Acquired with a NIDEK AFC-230 — 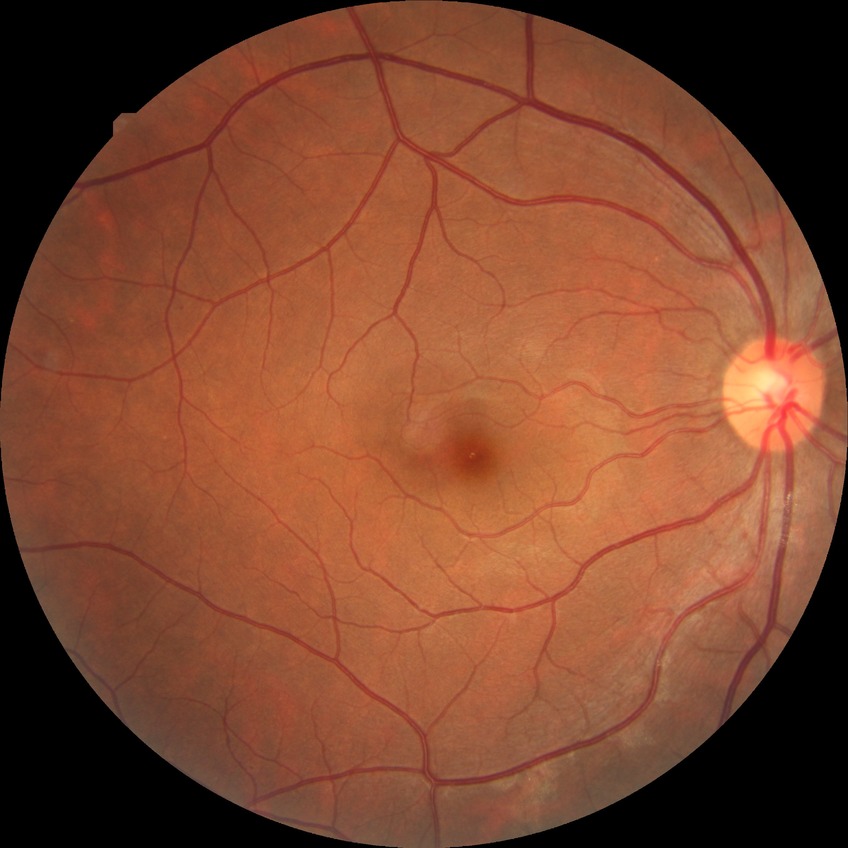
diabetic retinopathy (DR)=NDR (no diabetic retinopathy).